Diabetic retinopathy graded by the modified Davis classification; nonmydriatic:
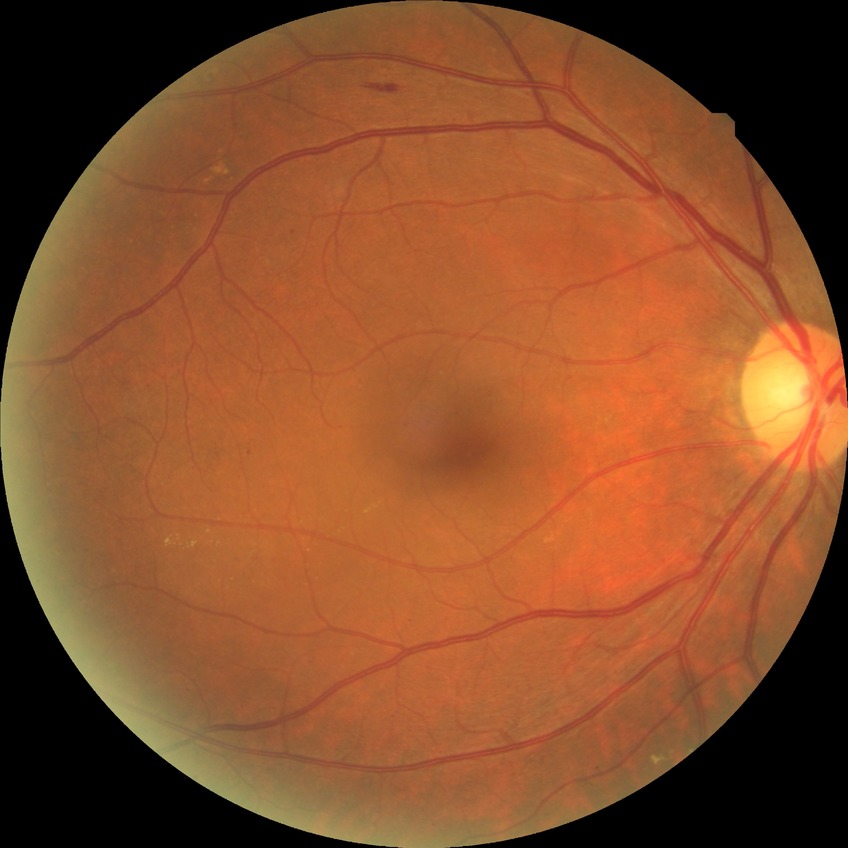

proliferative_class: non-proliferative diabetic retinopathy
davis_grade: SDR (simple diabetic retinopathy)